FOV: 45 degrees · DR severity per modified Davis staging
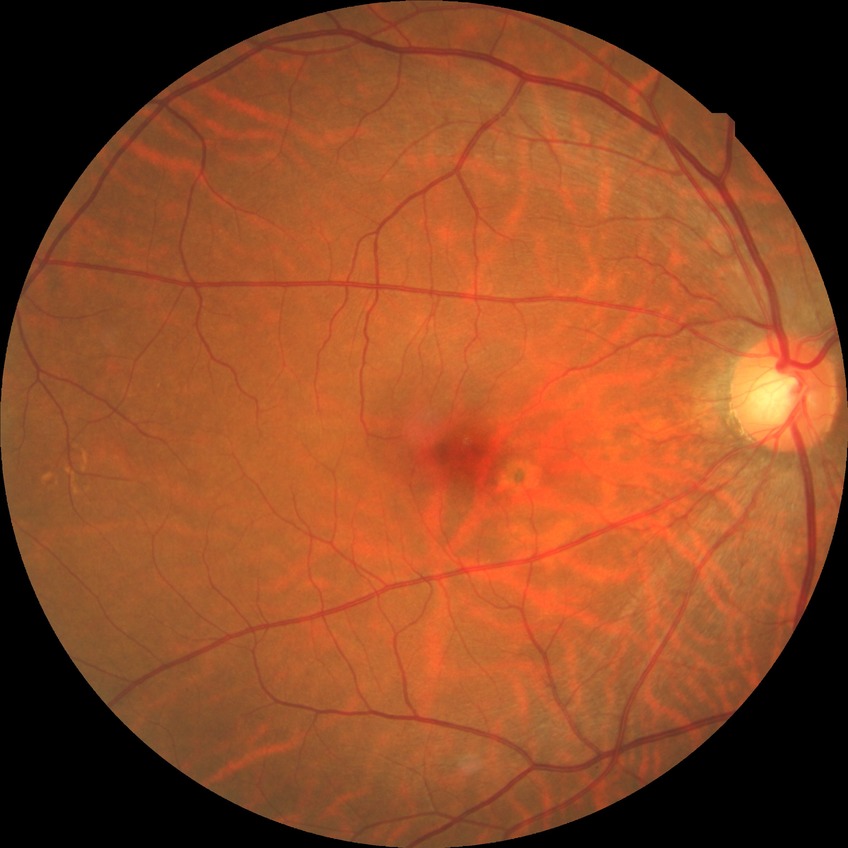 Diabetic retinopathy (DR): NDR (no diabetic retinopathy).